45-degree field of view, 2352 by 1568 pixels:
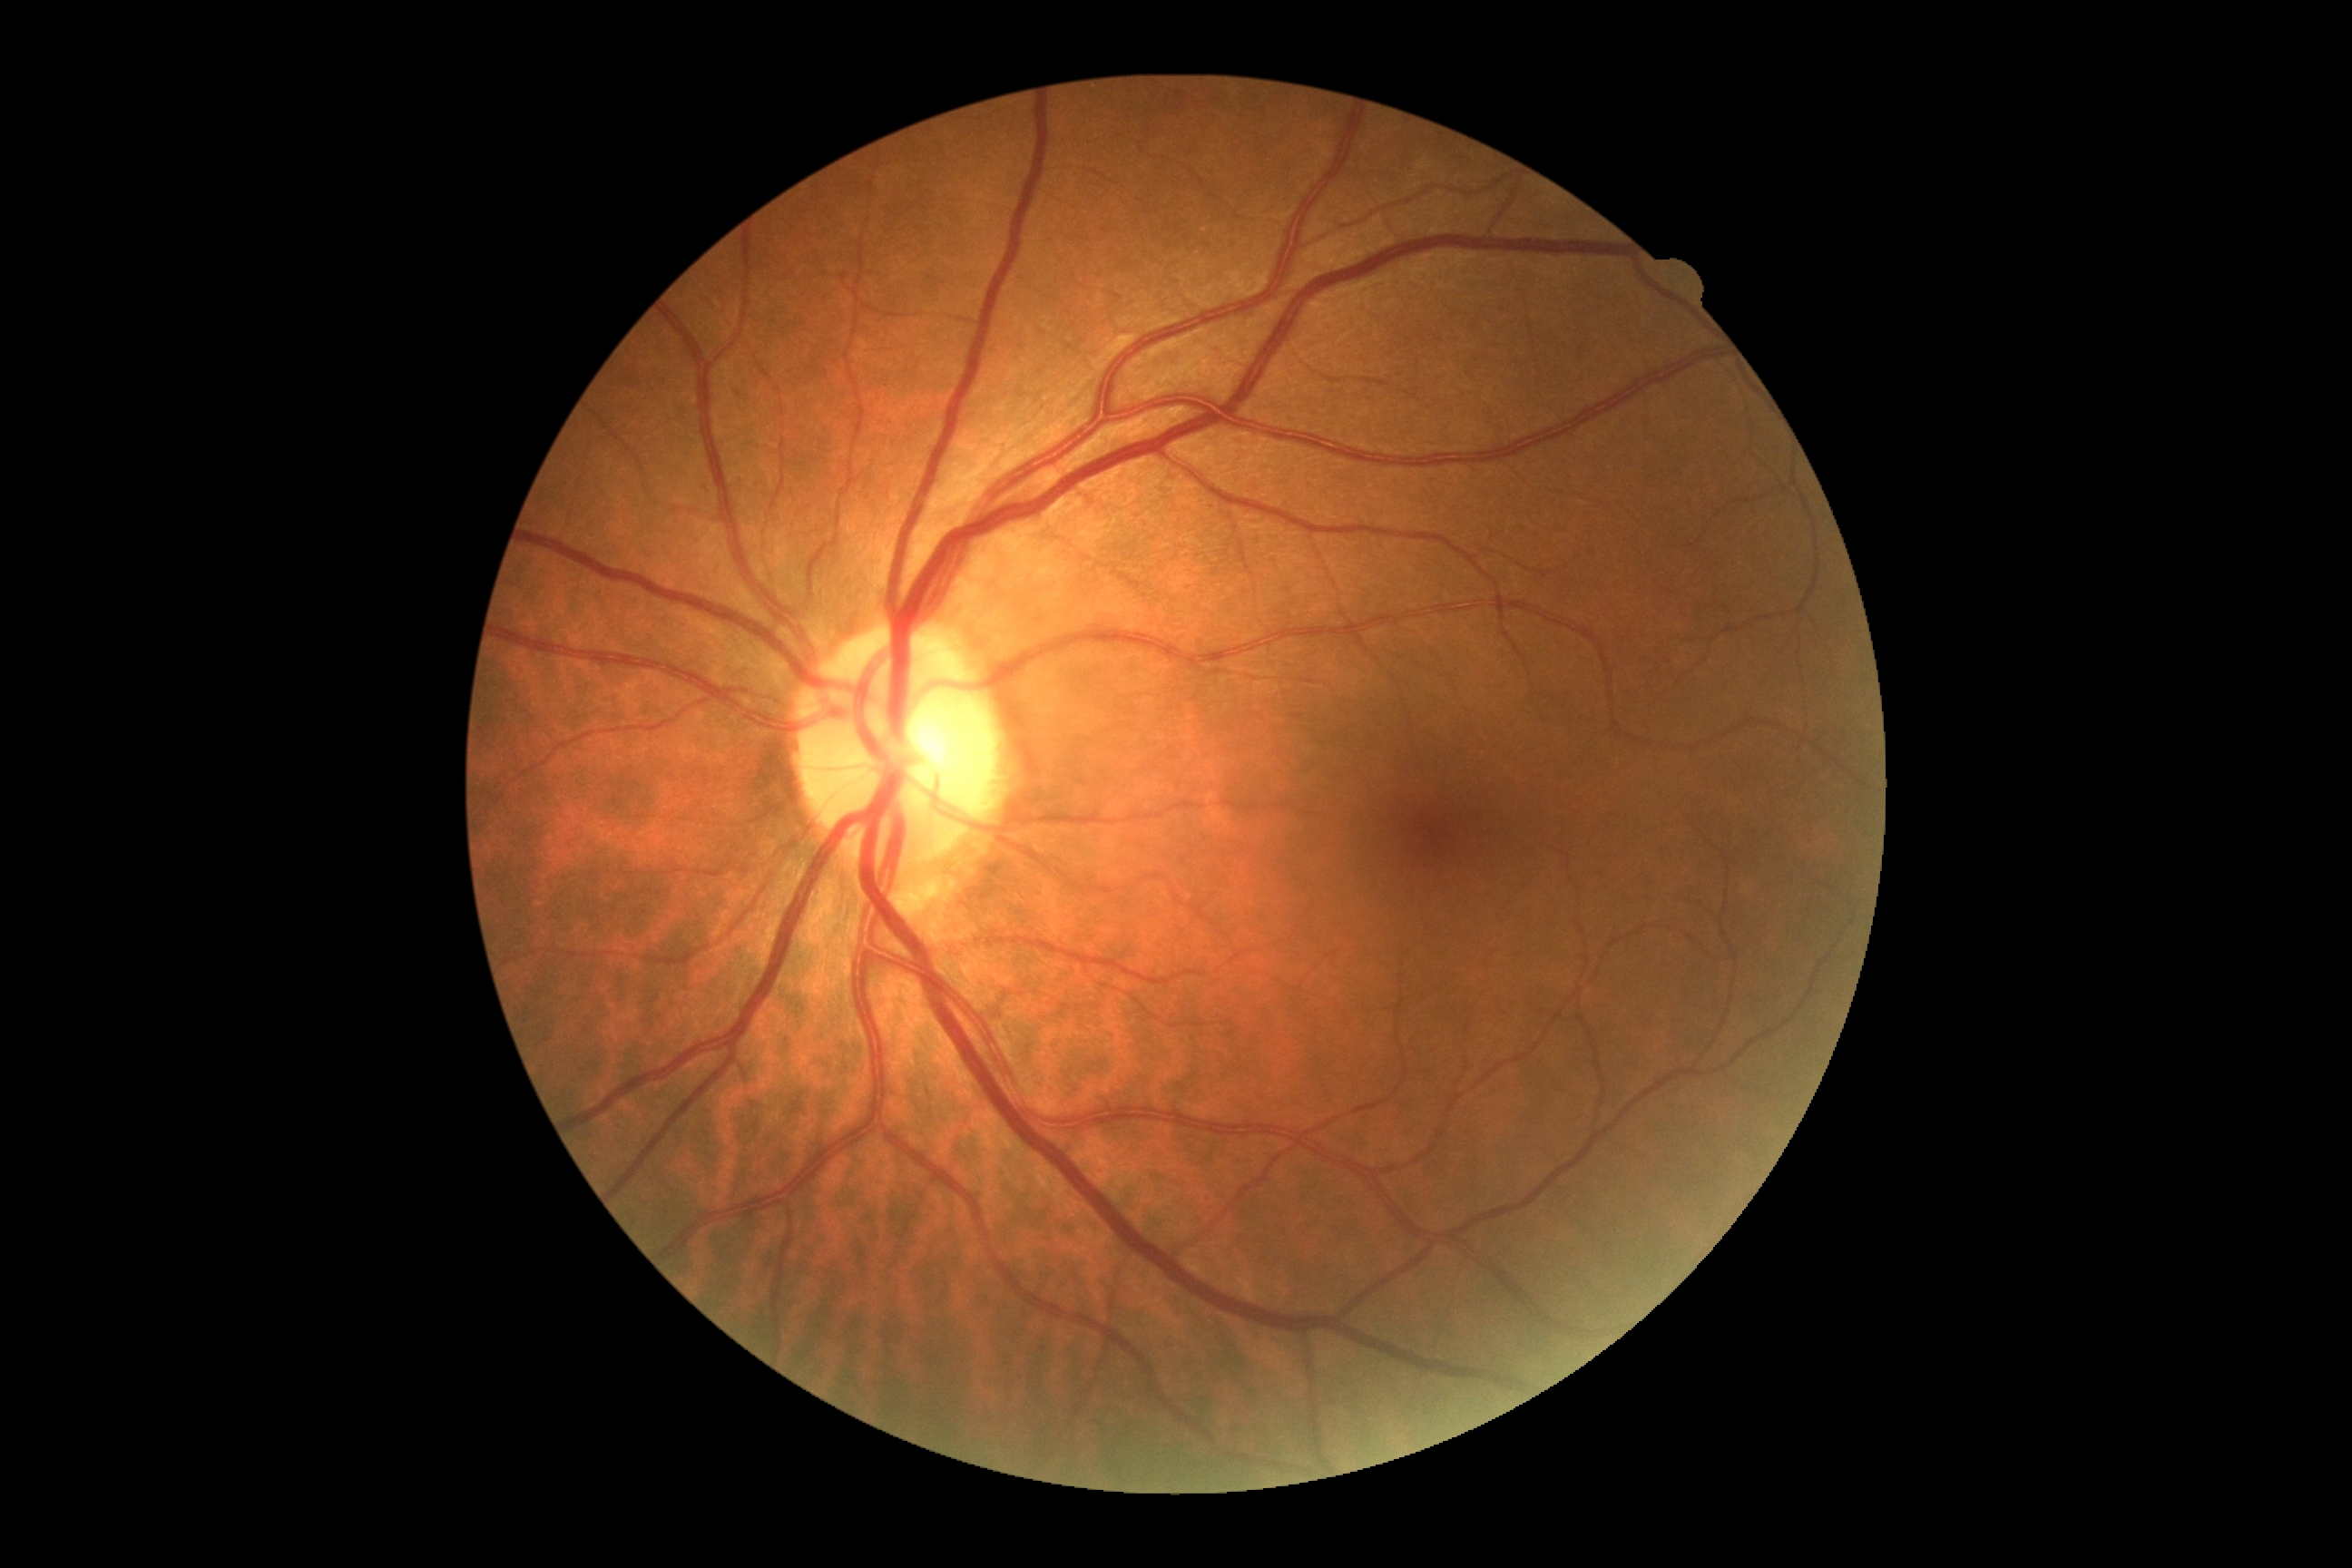

DR impression = negative for DR; DR grade = 0.